Image size 1659x2212: 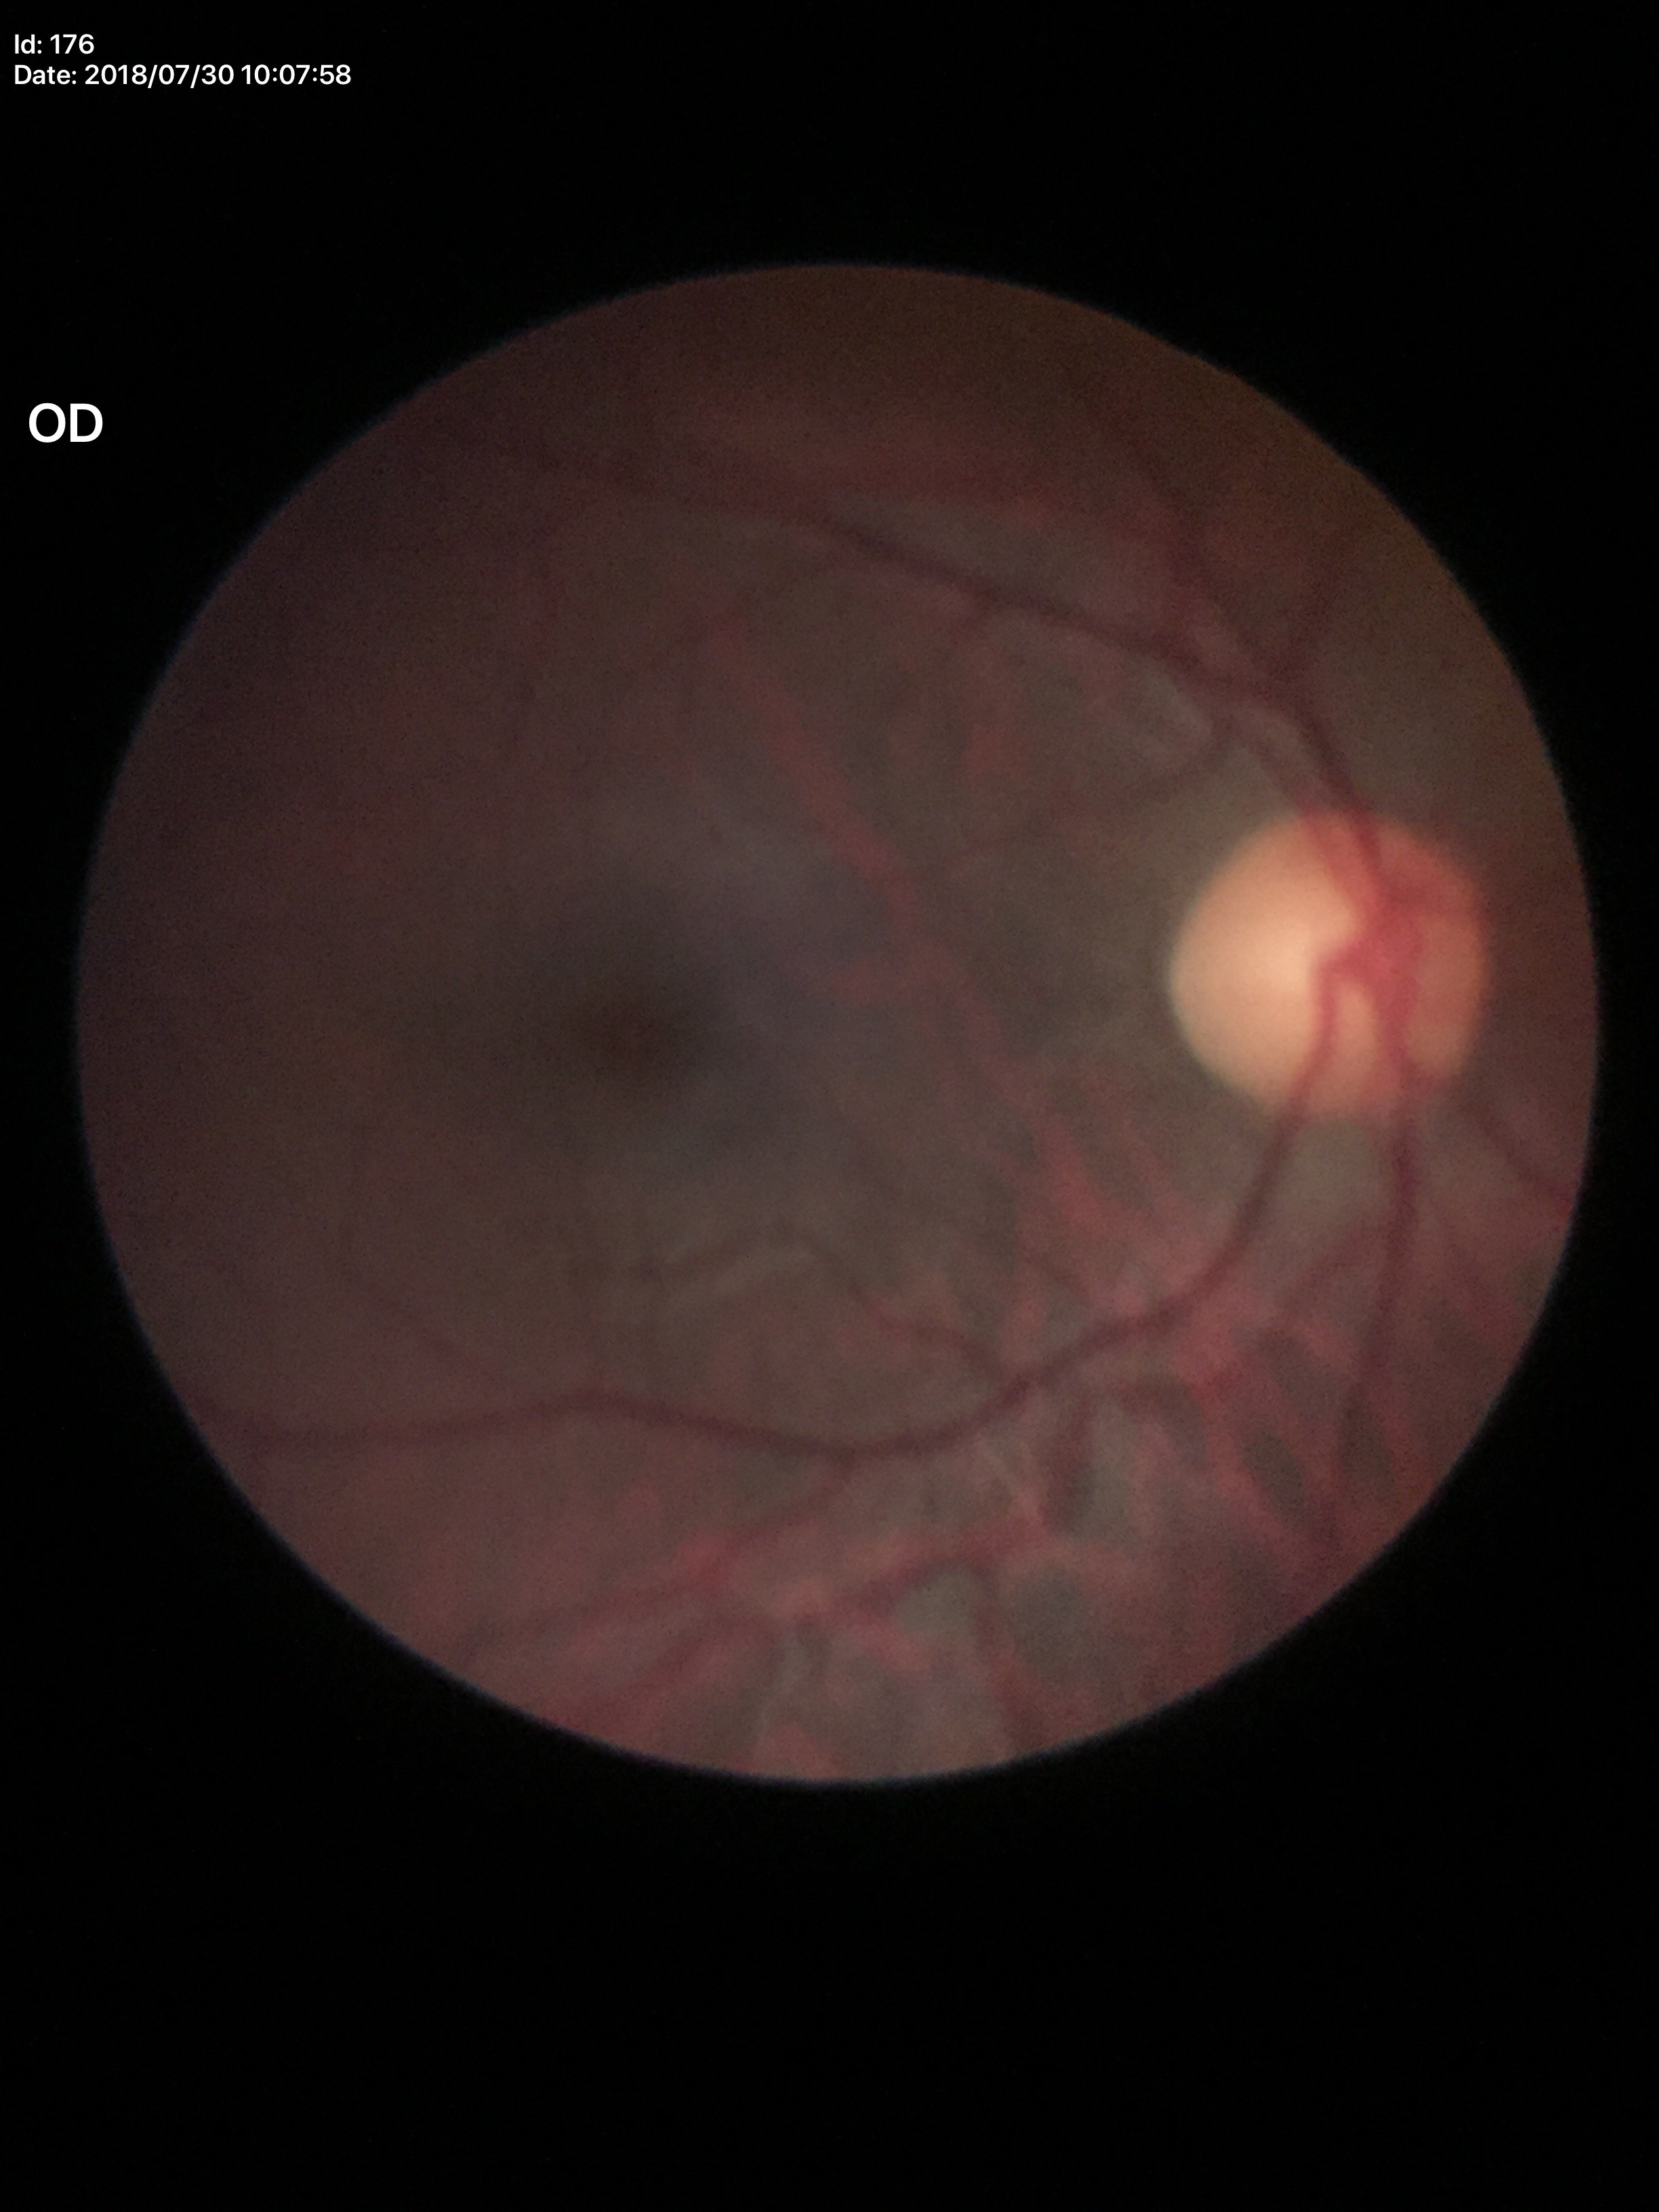

Glaucoma screening: negative. Vertical cup-disc ratio of 0.50.